Pediatric retinal photograph (wide-field).
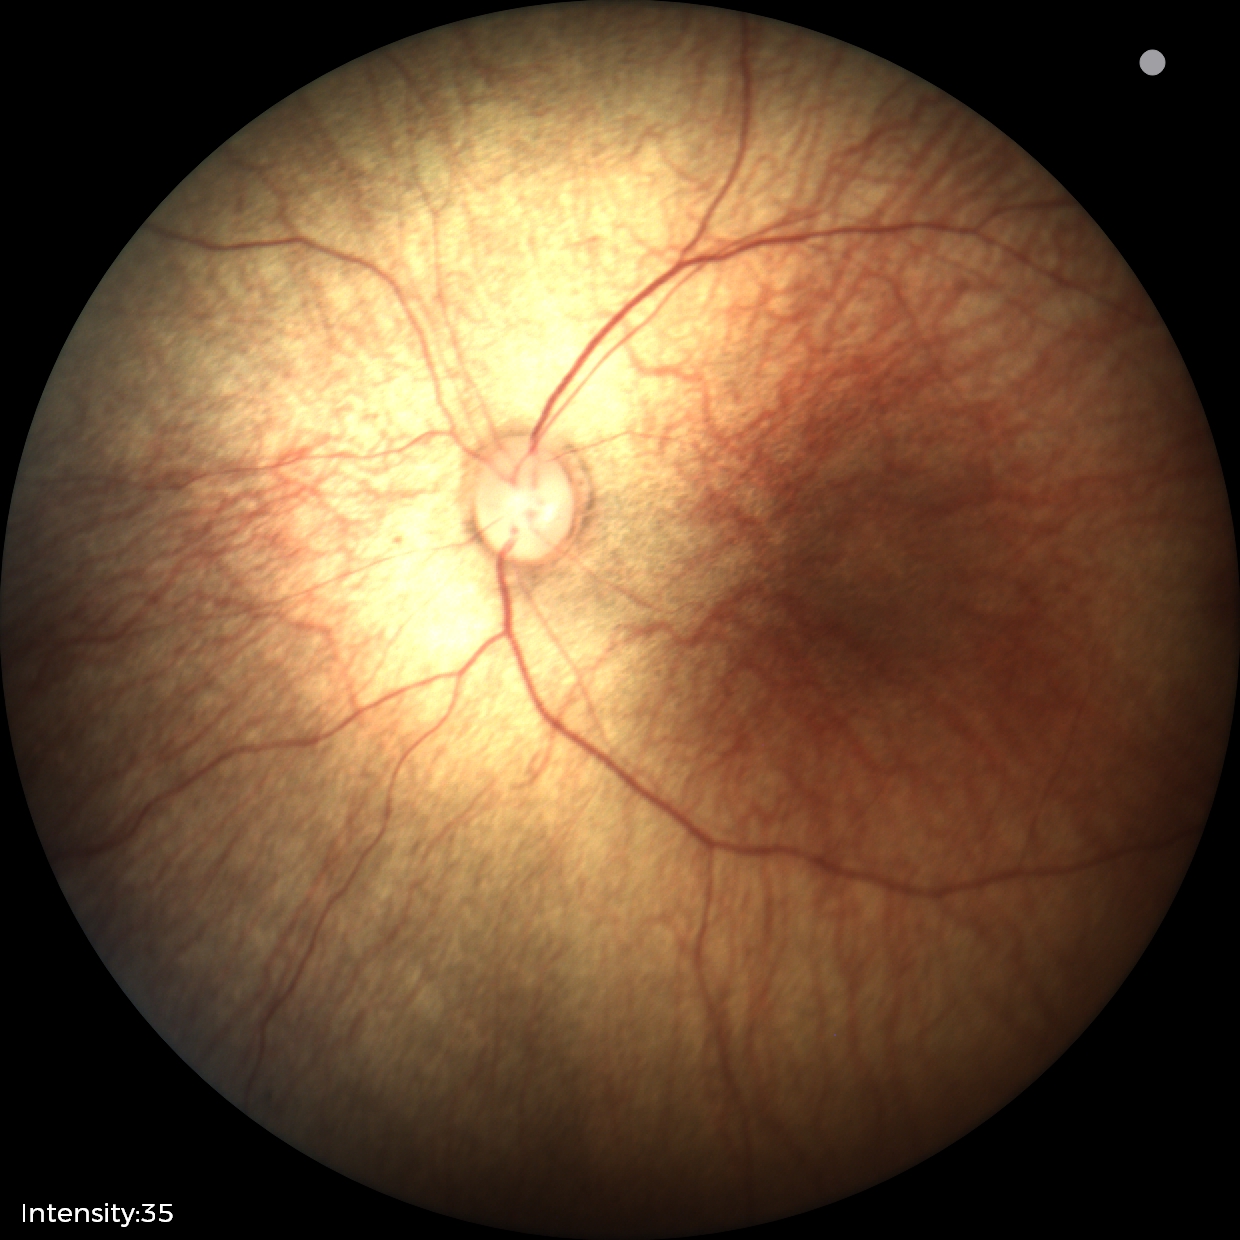 Assessment = normal